Phoenix ICON wide-field infant fundus image · 100° field of view (Phoenix ICON): 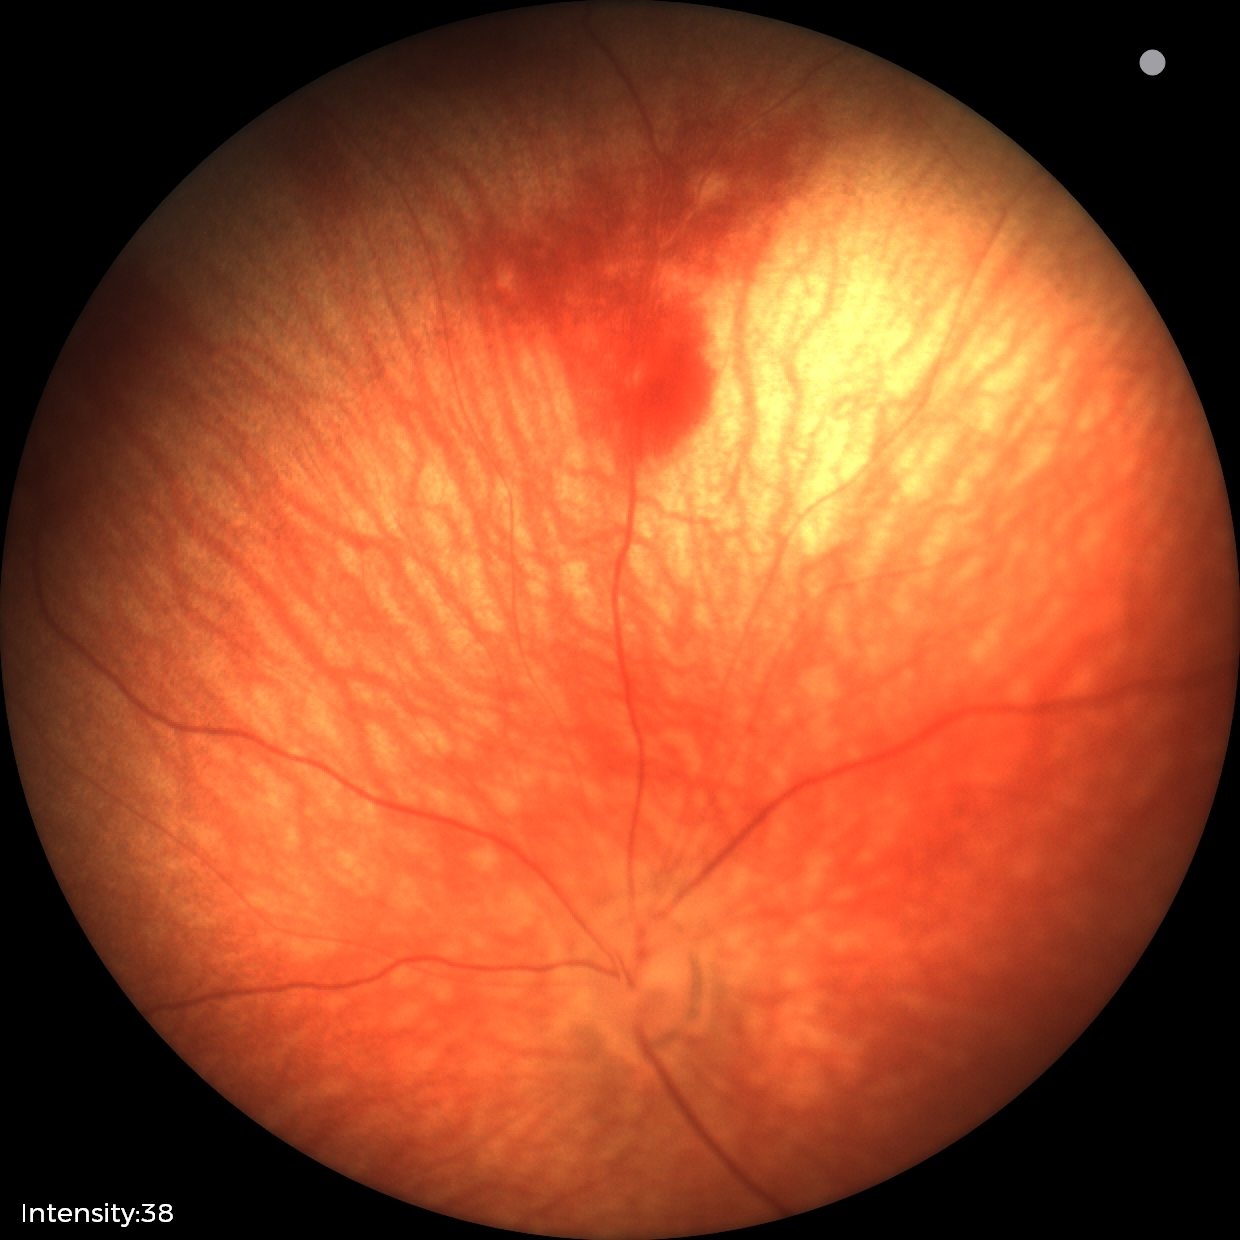 Examination diagnosed as retinal hemorrhages.